Modified Davis grading, no pharmacologic dilation:
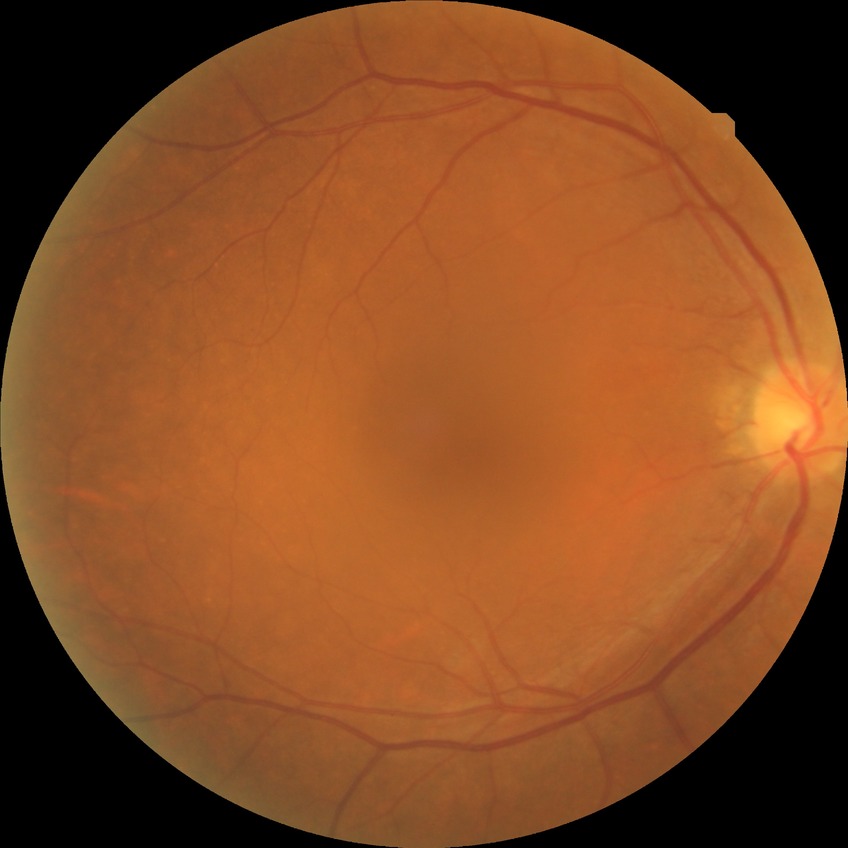

DR stage@NDR.